DR severity per modified Davis staging:
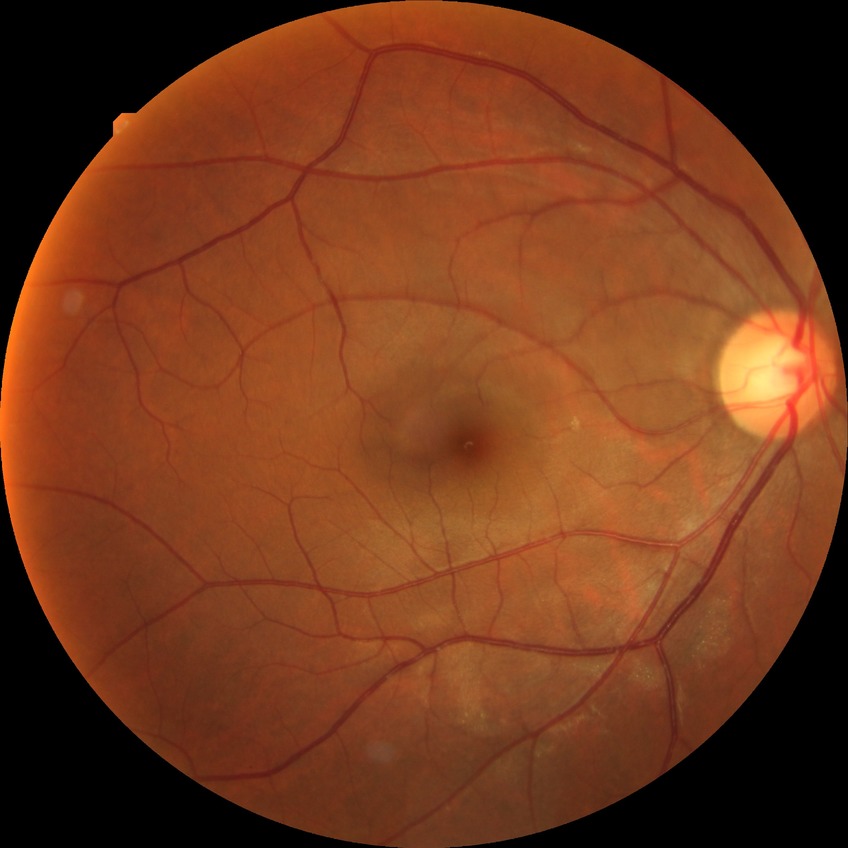

  davis_grade: no diabetic retinopathy (NDR)